Modified Davis classification:
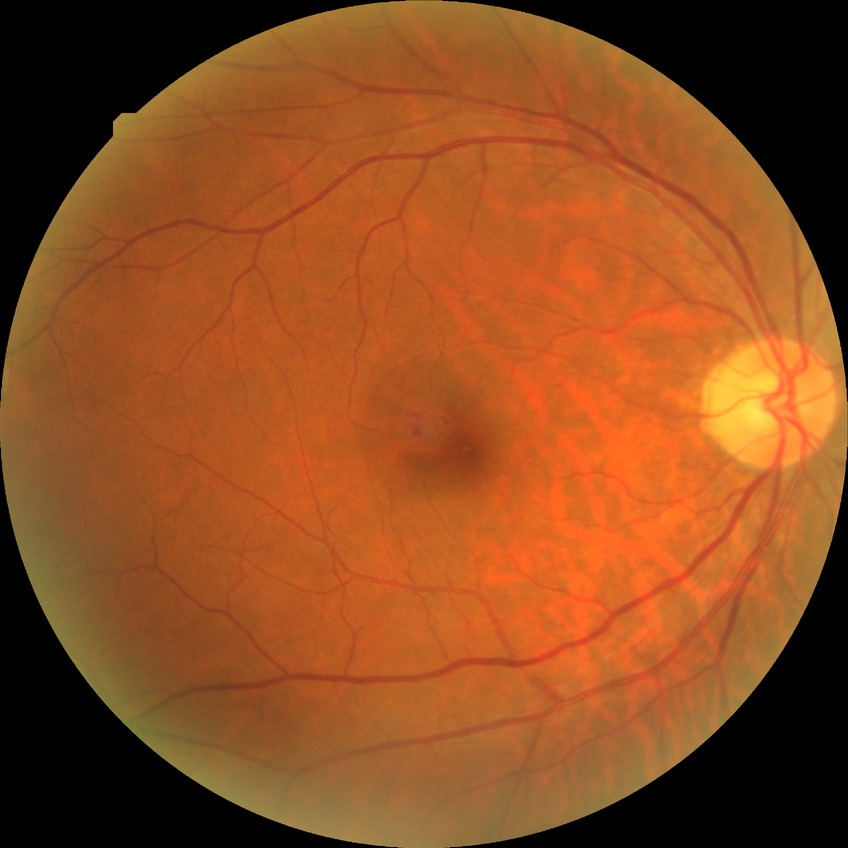 {
  "davis_grade": "simple diabetic retinopathy (SDR)"
}